Retinal fundus photograph — 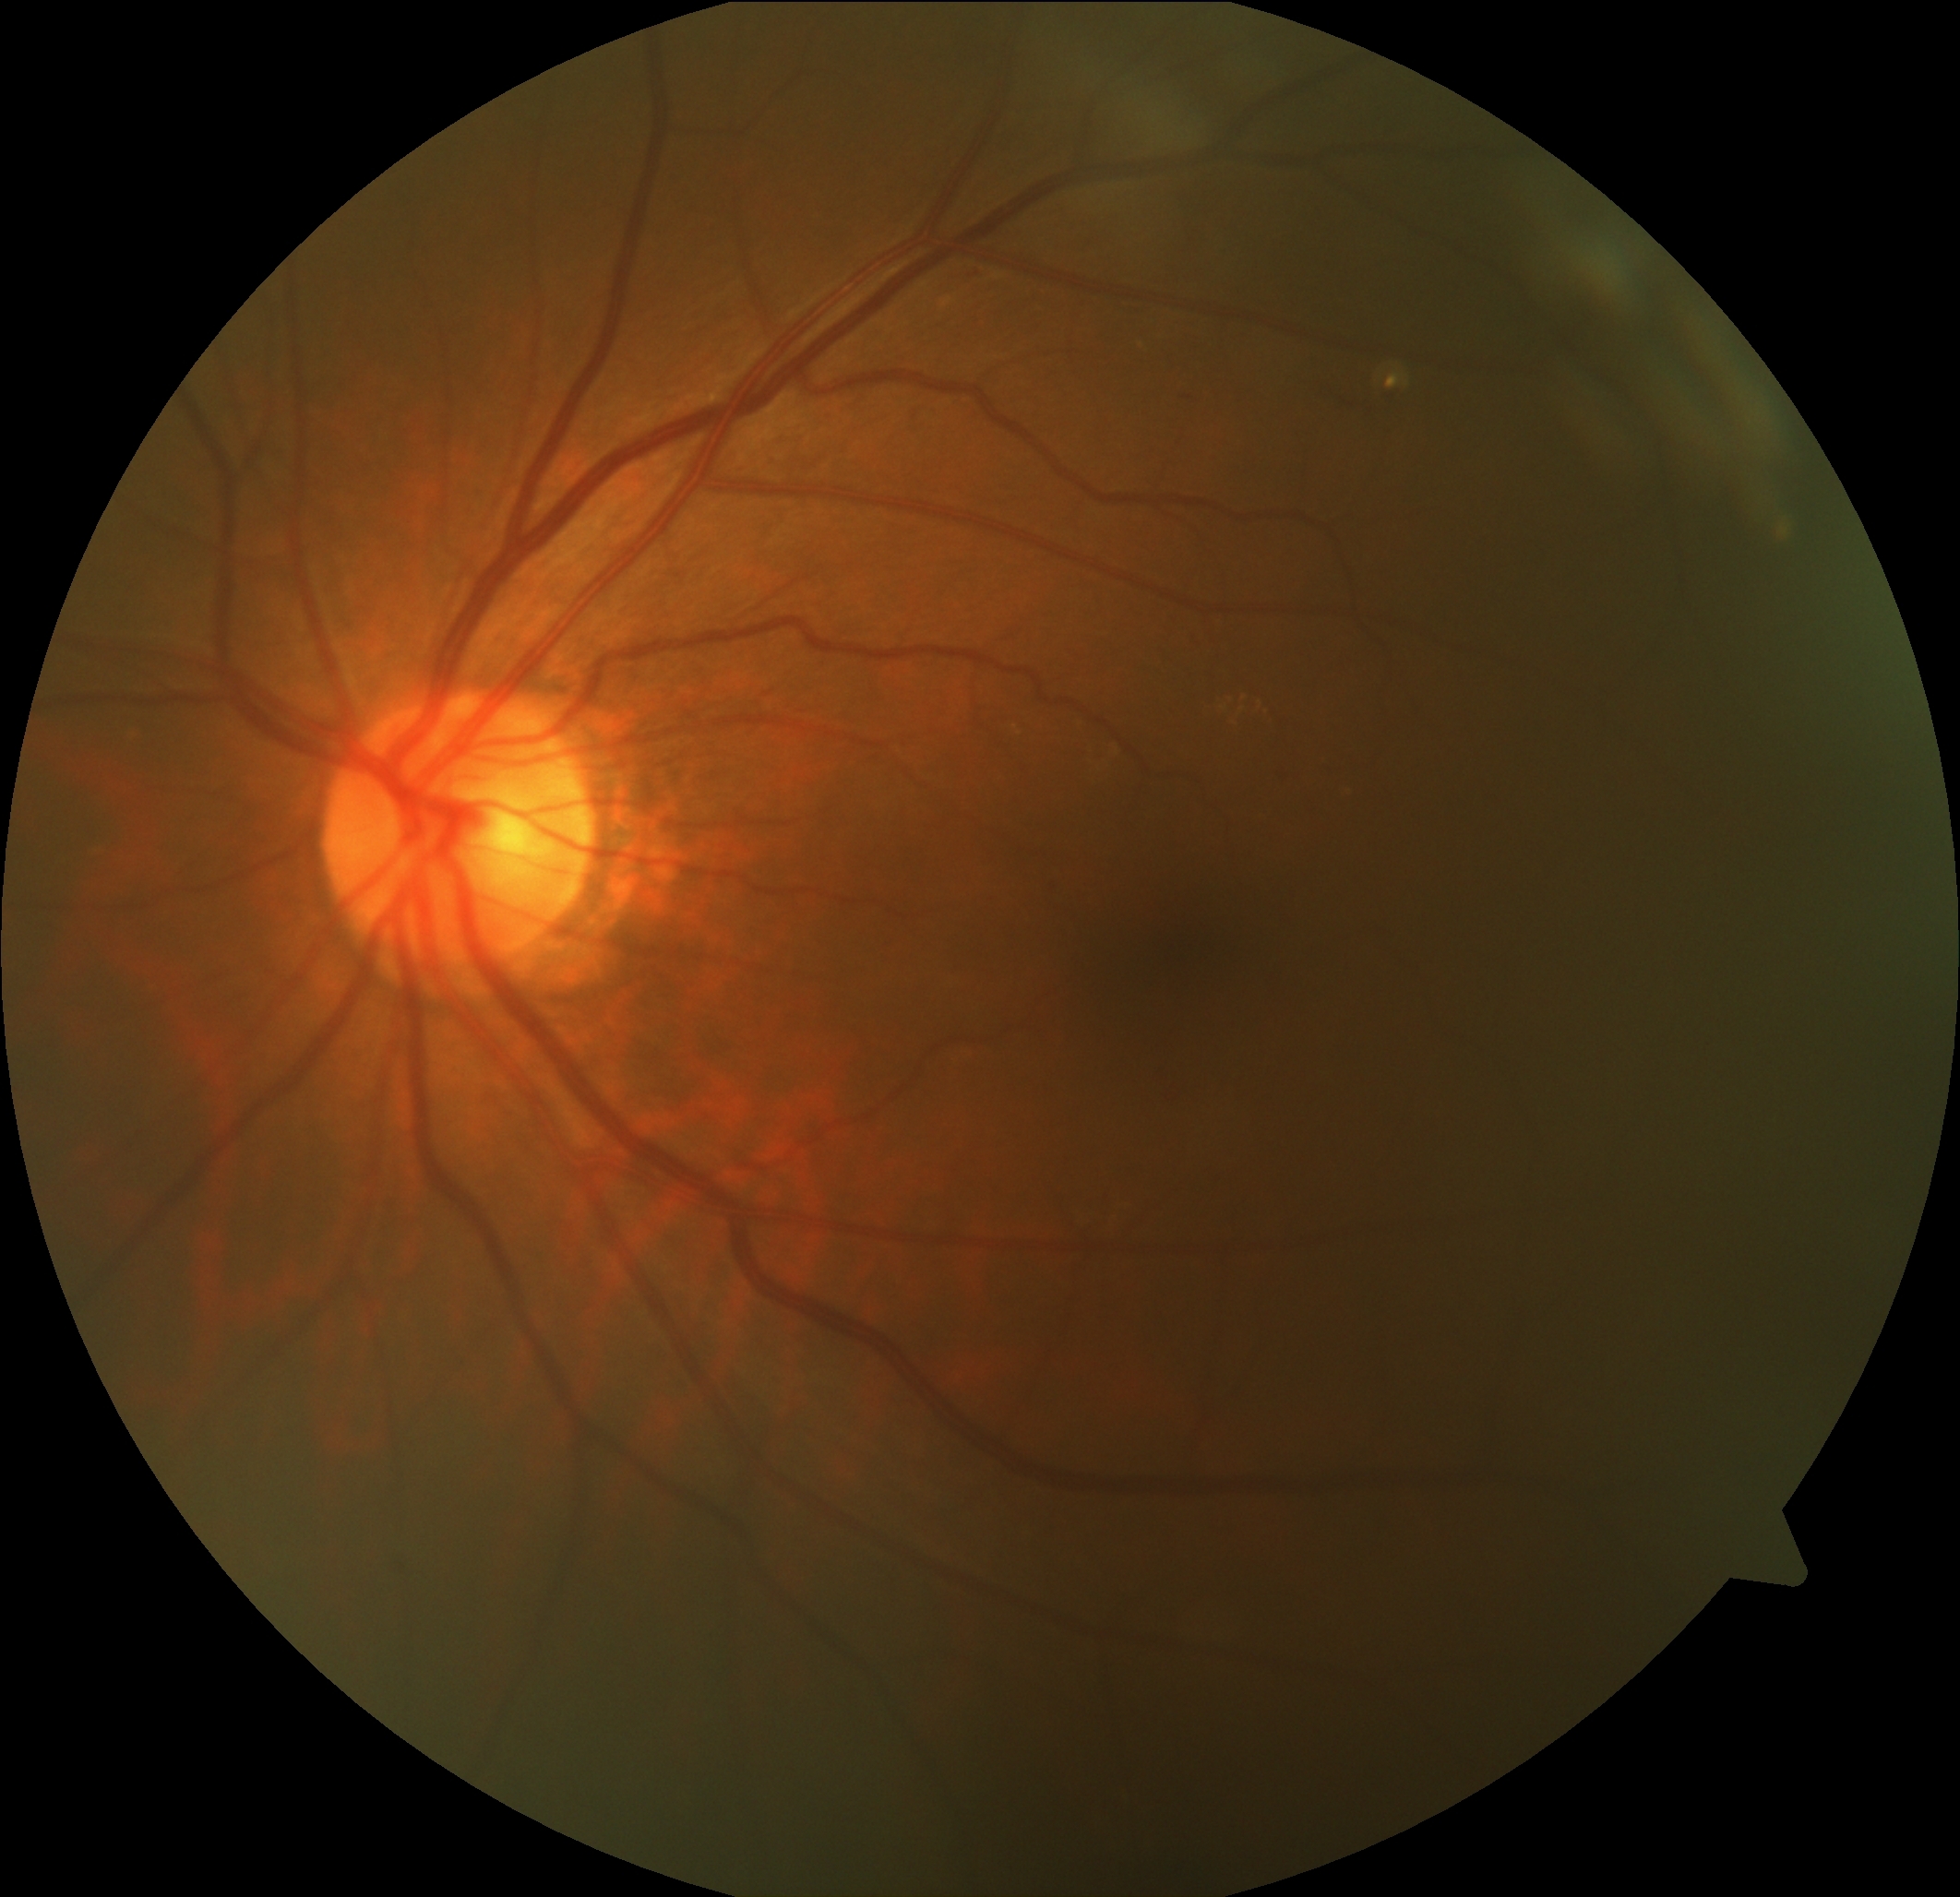

Findings:
– DR class: non-proliferative diabetic retinopathy
– DR: 2/4